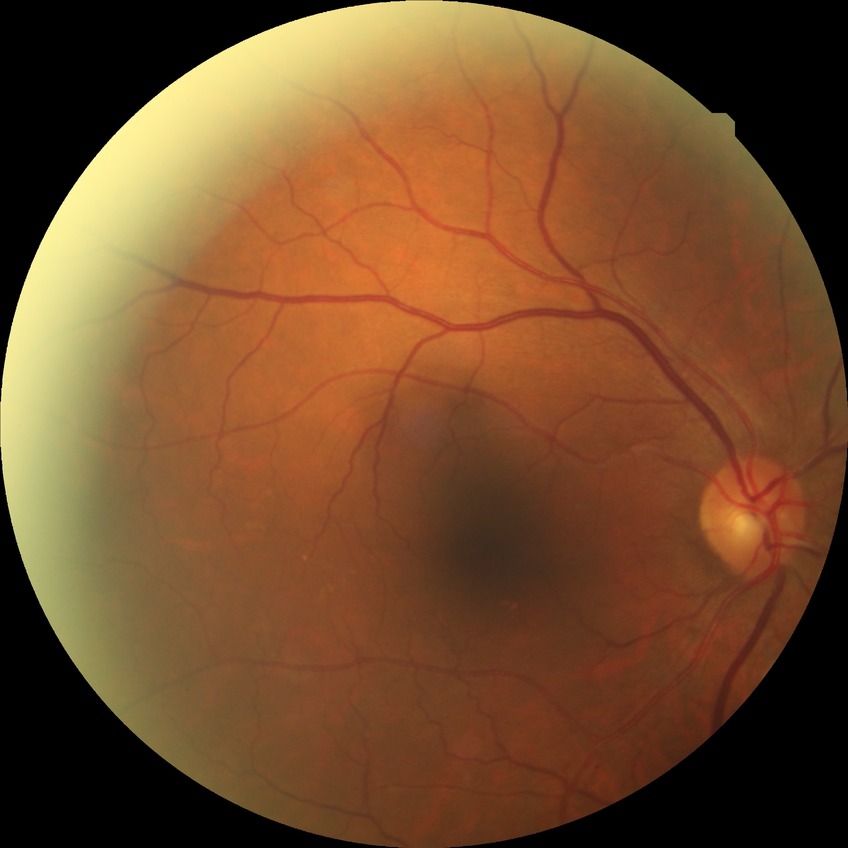

Diabetic retinopathy (DR) is no diabetic retinopathy (NDR).